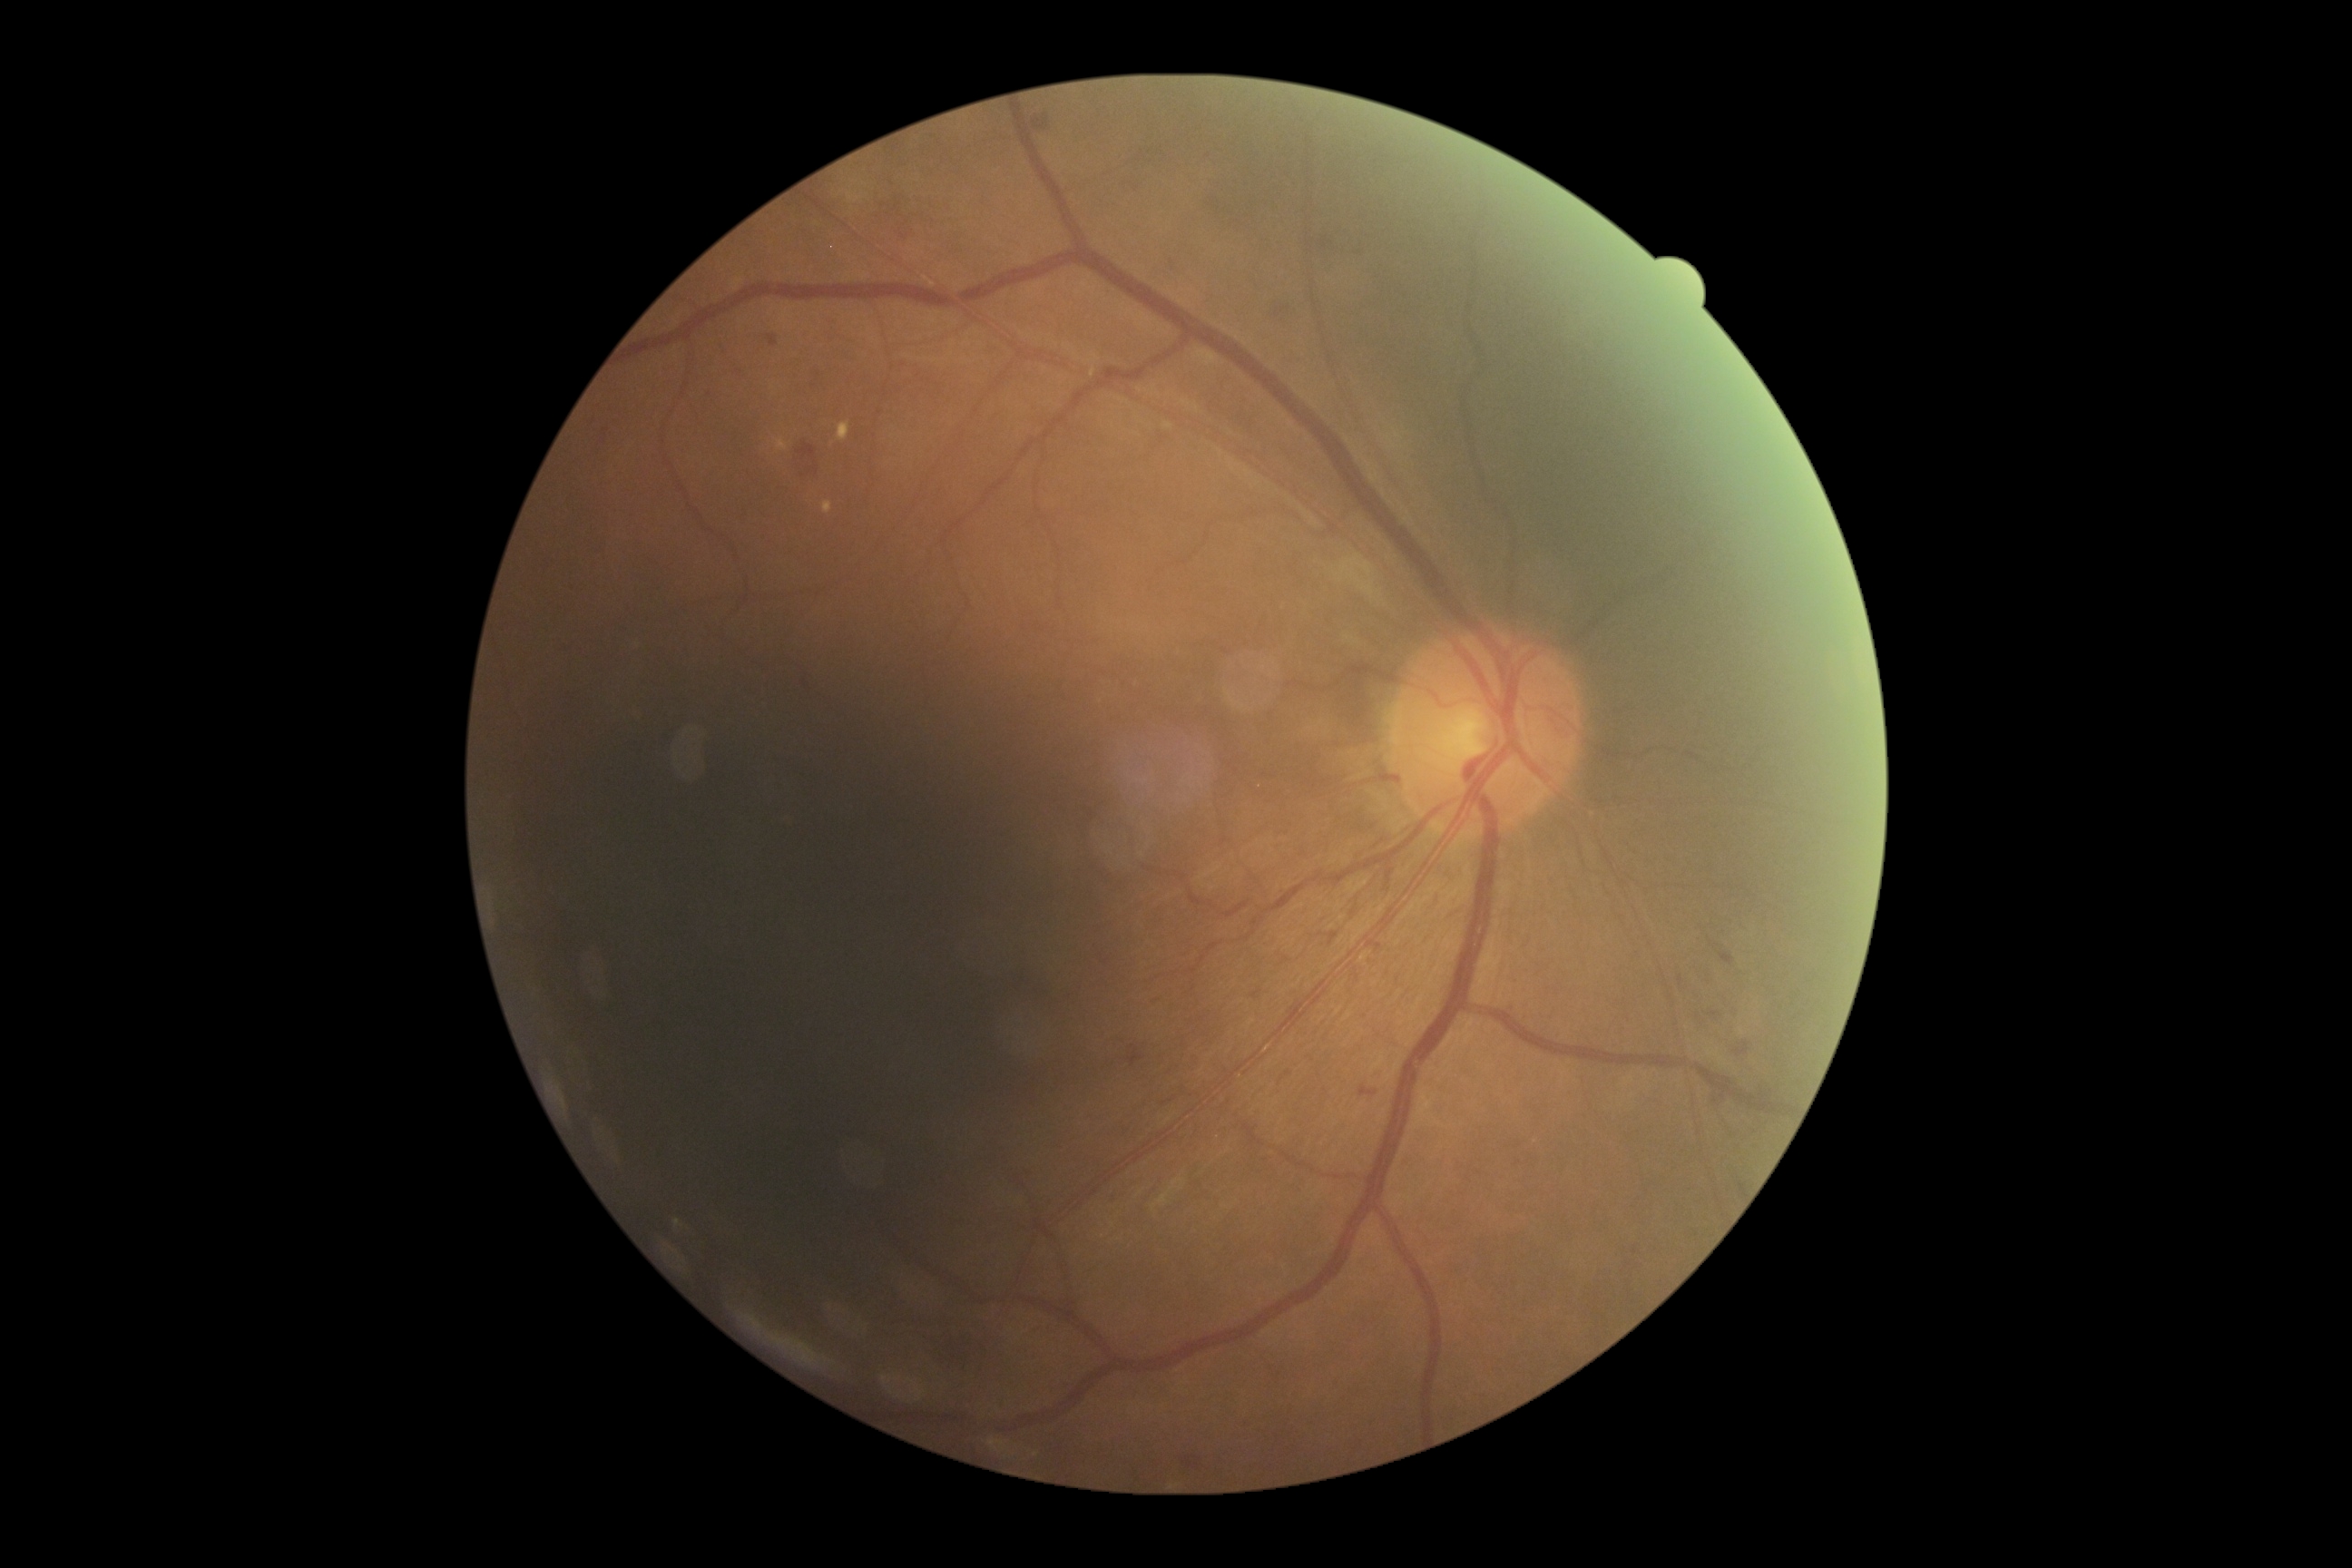
DR stage is grade 2 (moderate NPDR).